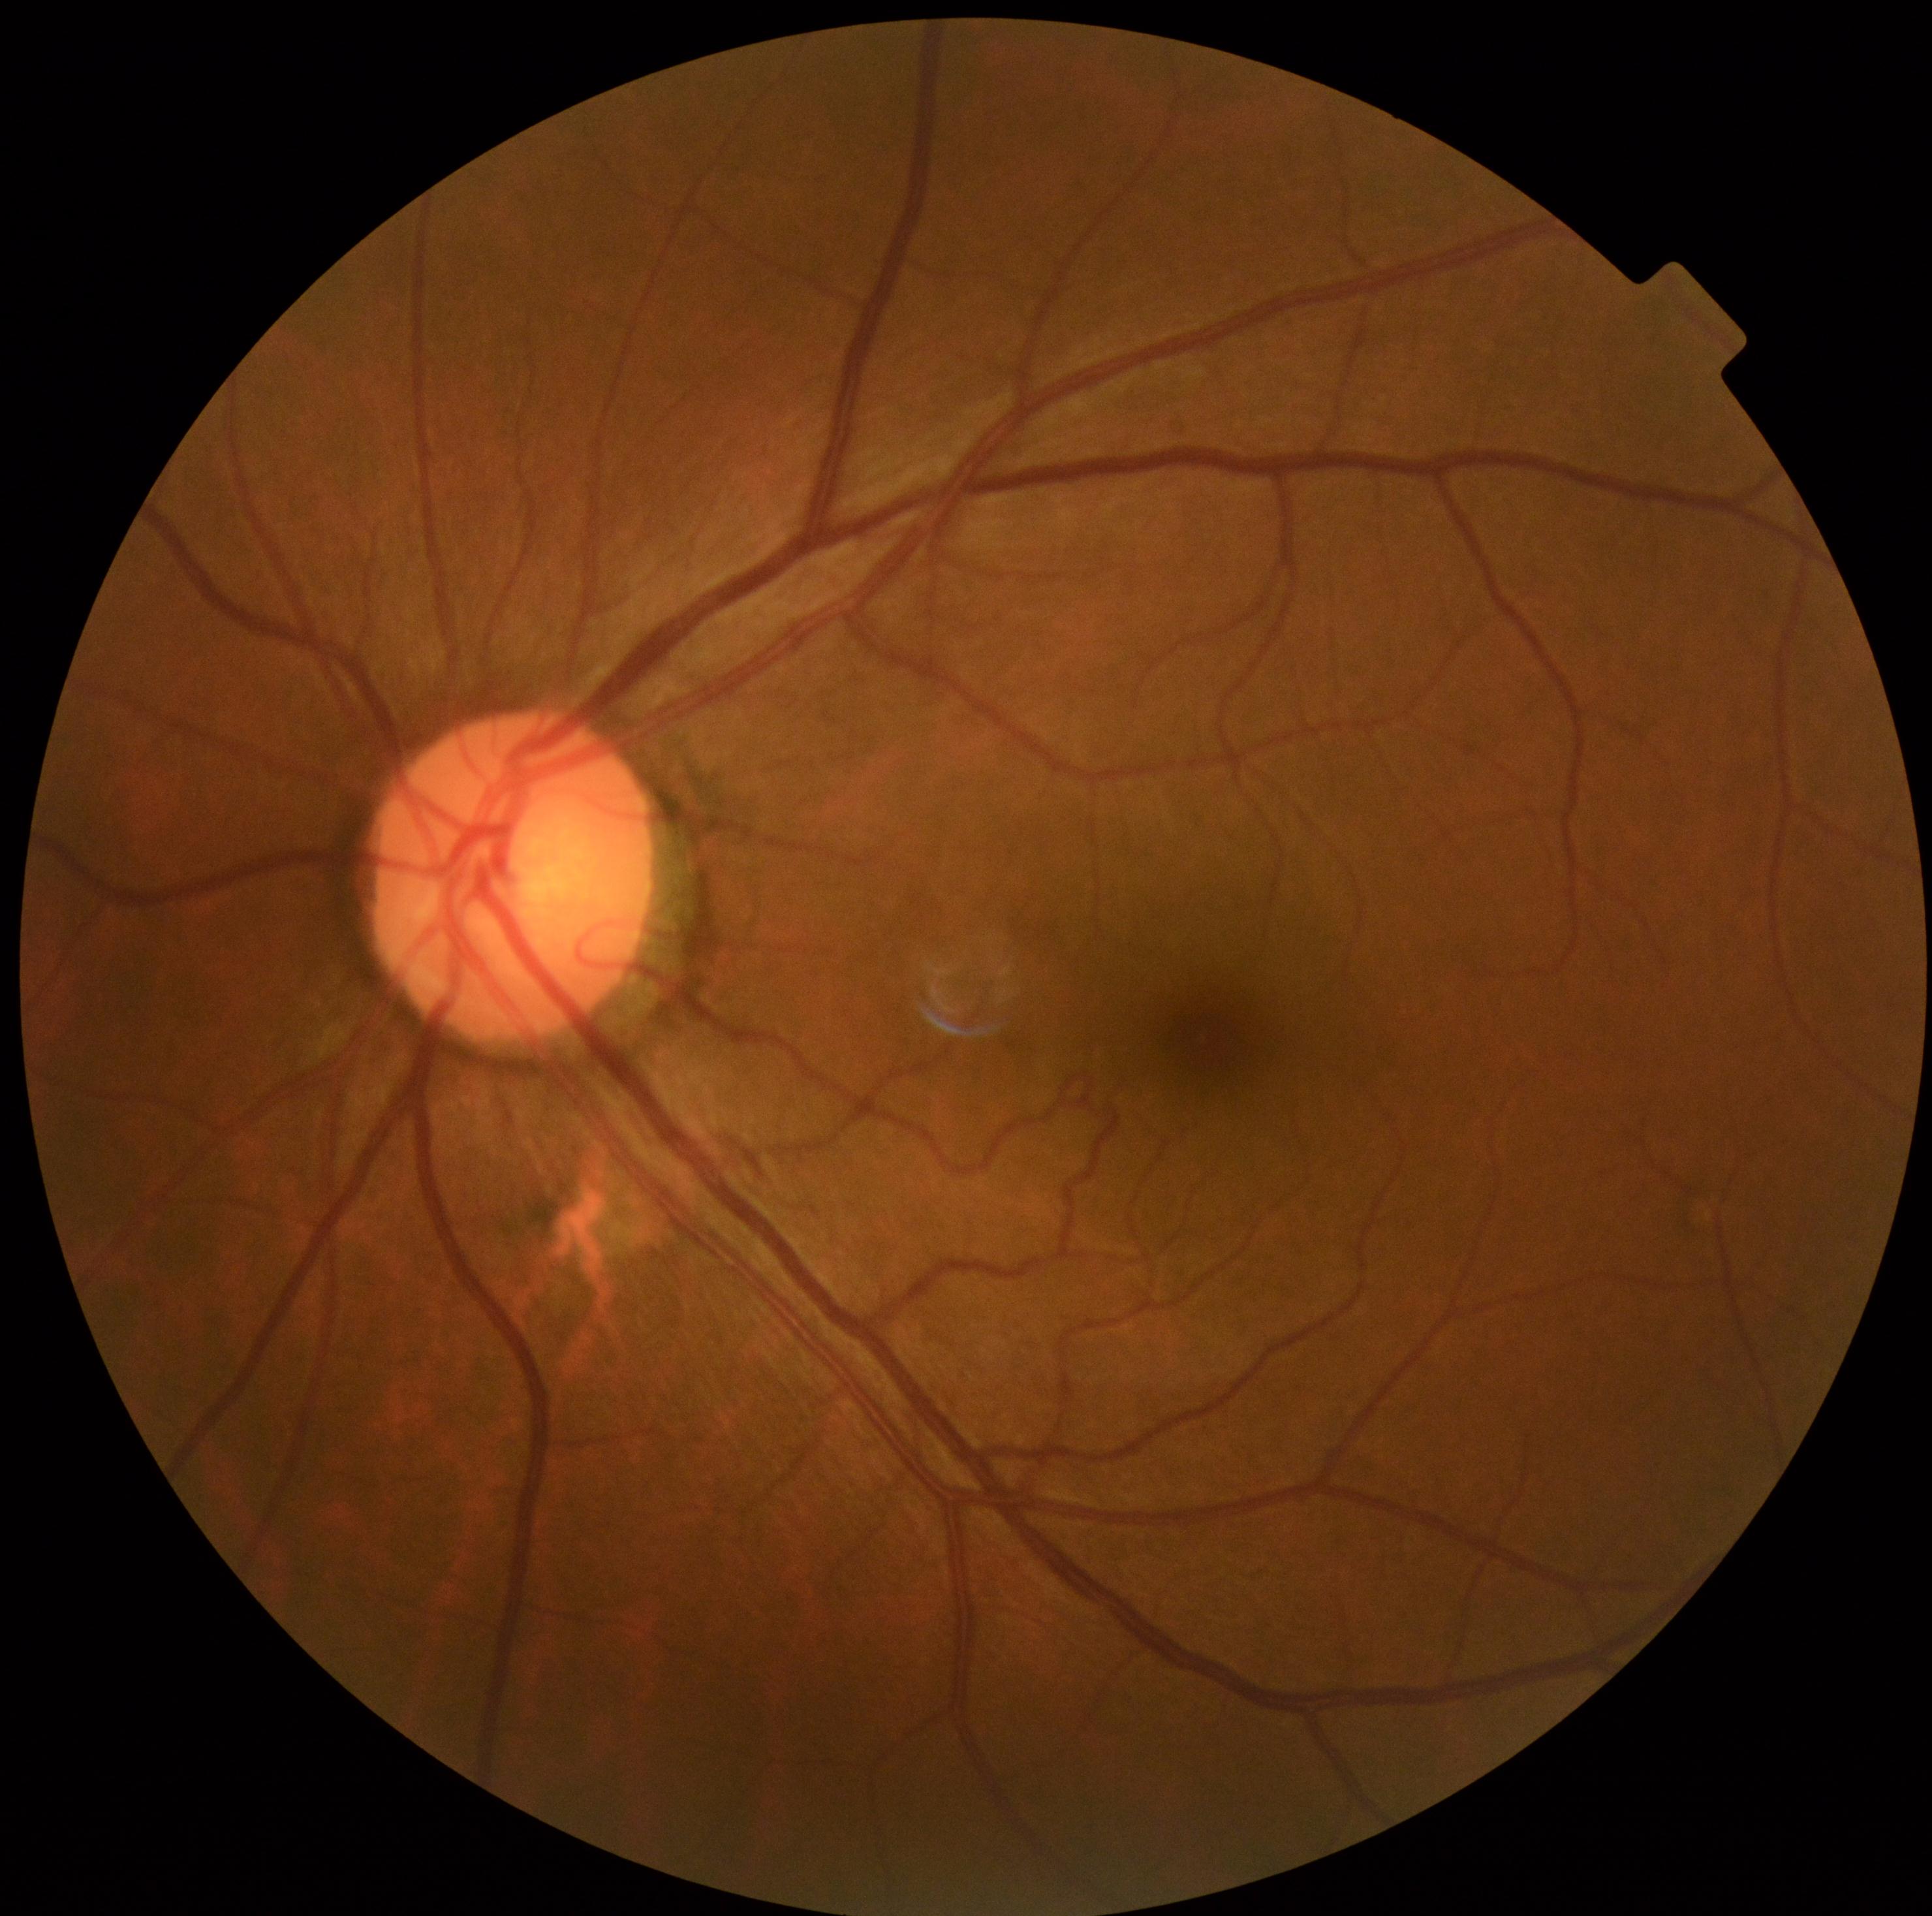 dr_grade: grade 0 (no apparent retinopathy)